1240 by 1240 pixels; pediatric wide-field fundus photograph
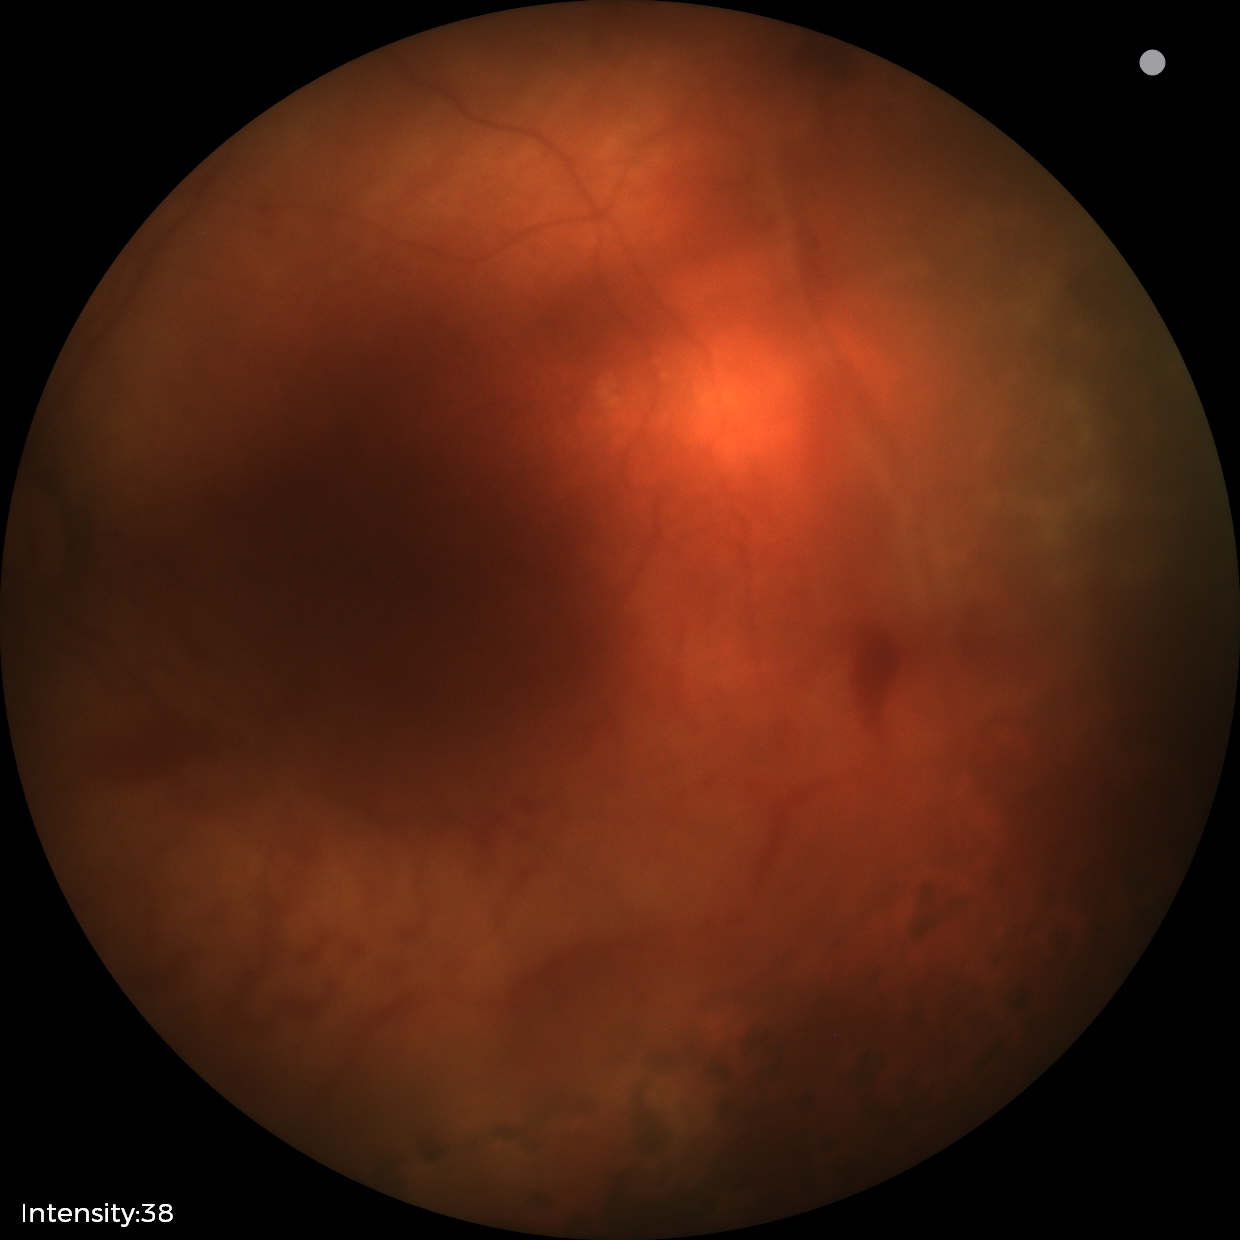

Series diagnosed as status post retinopathy of prematurity (ROP). No plus disease.